Captured with the Phoenix ICON (100° field of view); infant wide-field fundus photograph.
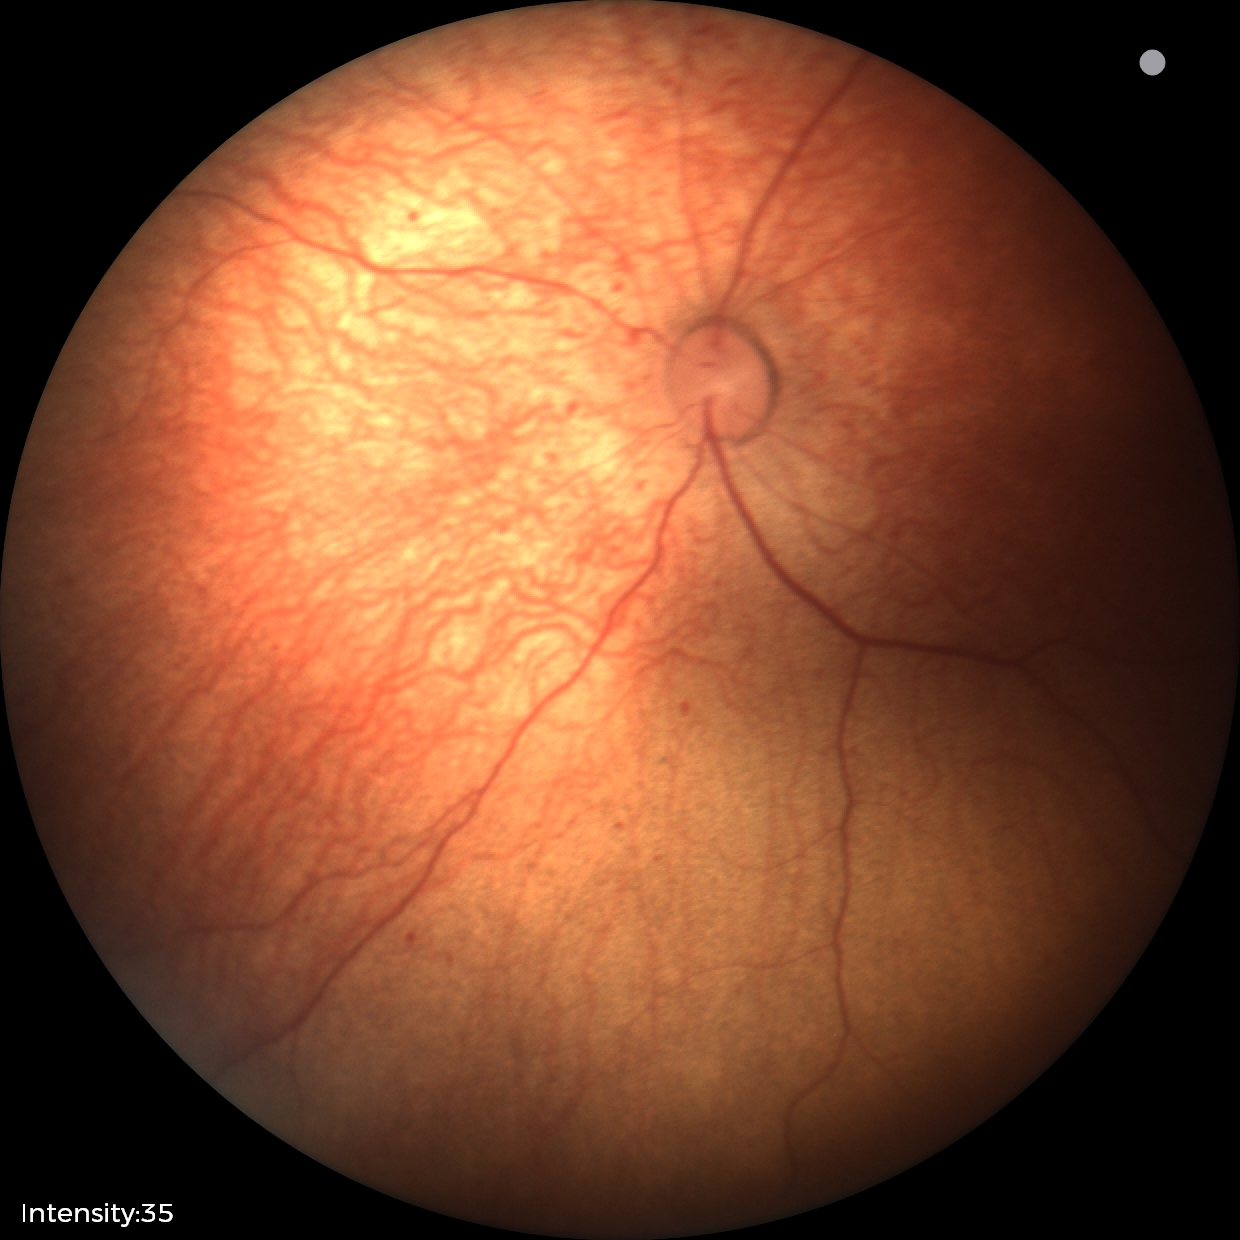

Without plus disease.
Examination diagnosed as status post ROP — retinal appearance after treated retinopathy of prematurity.